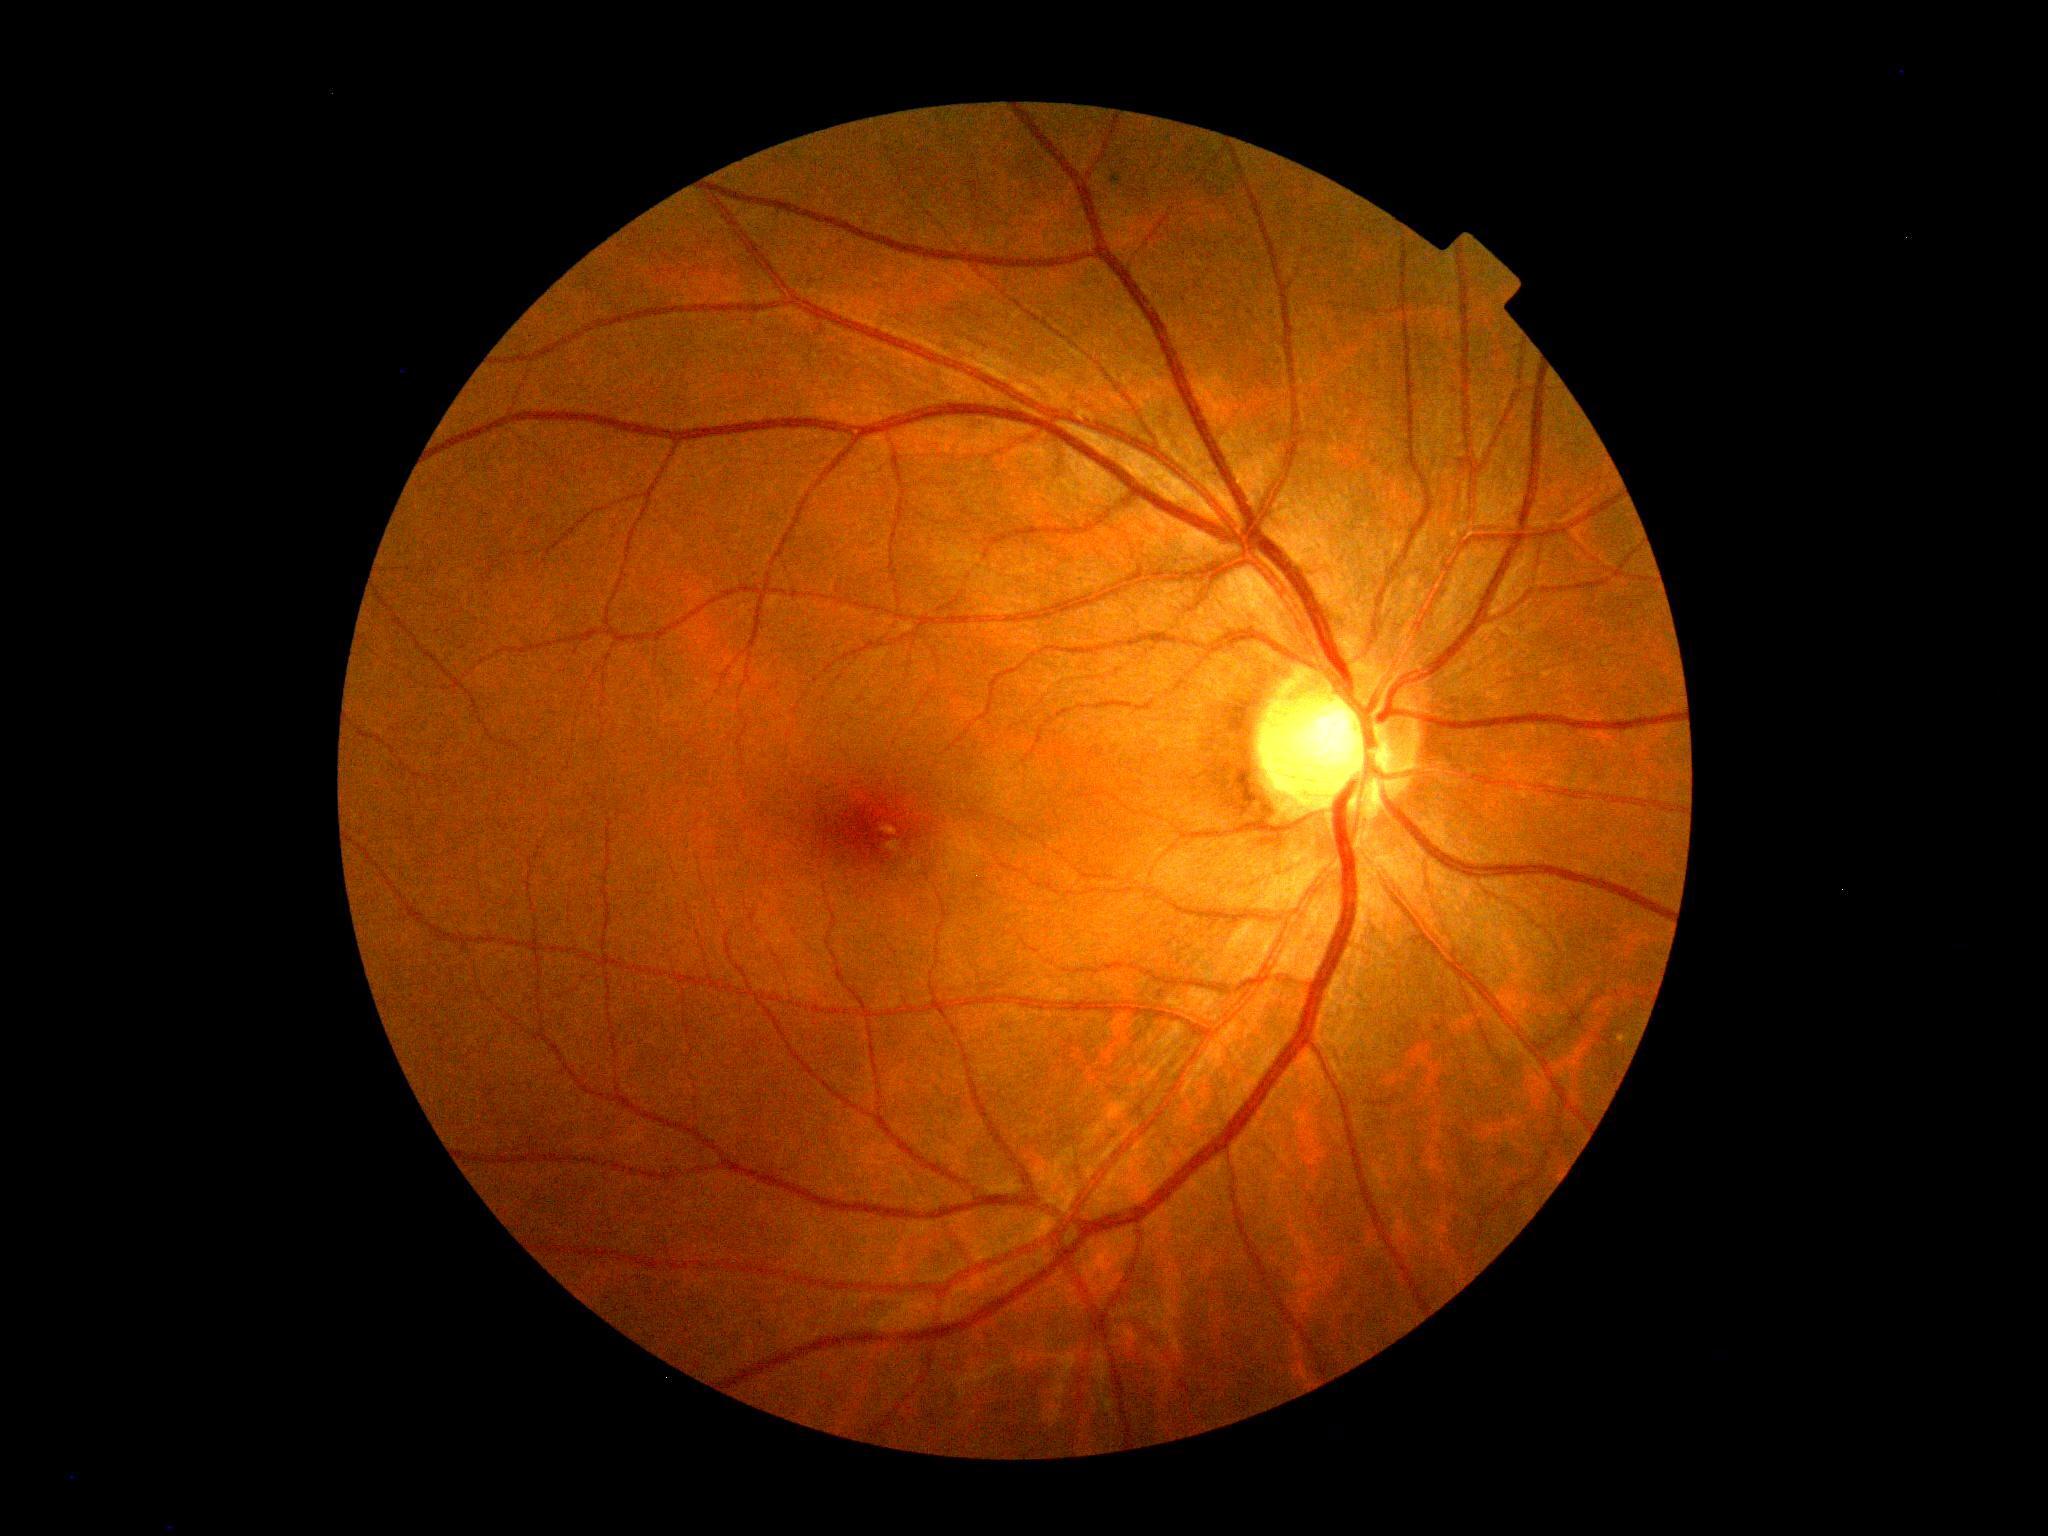
DR grade: 0.